Color fundus photograph.
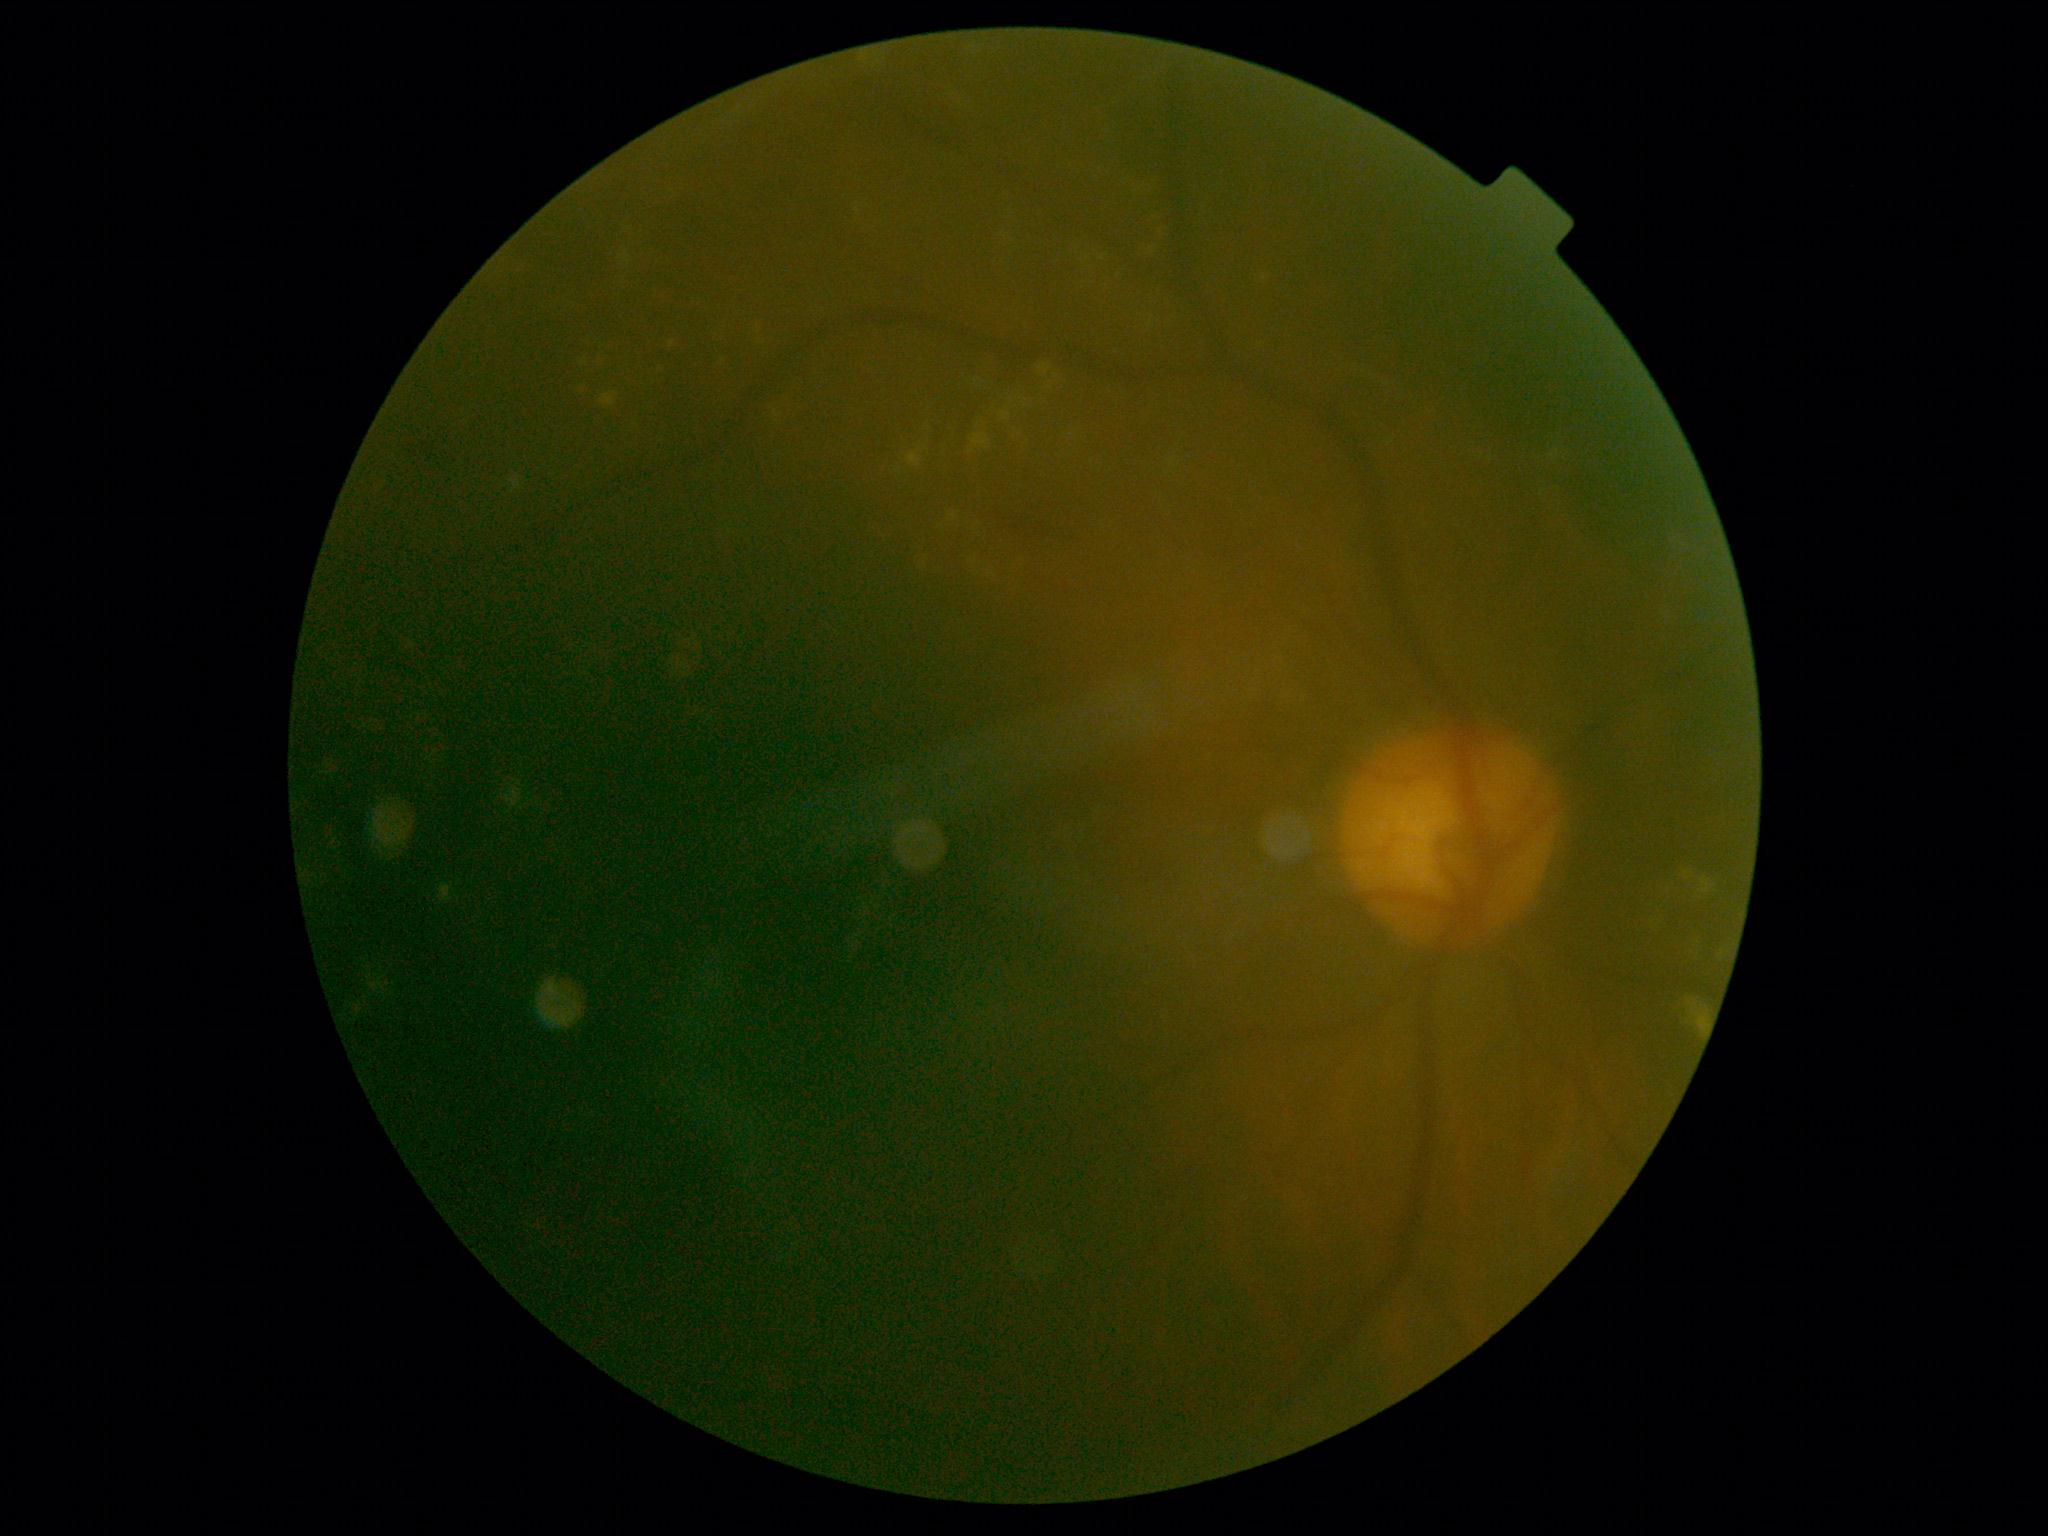
diabetic retinopathy (DR)@grade 2 (moderate NPDR).